200-degree field of view. 1924 x 1556 pixels
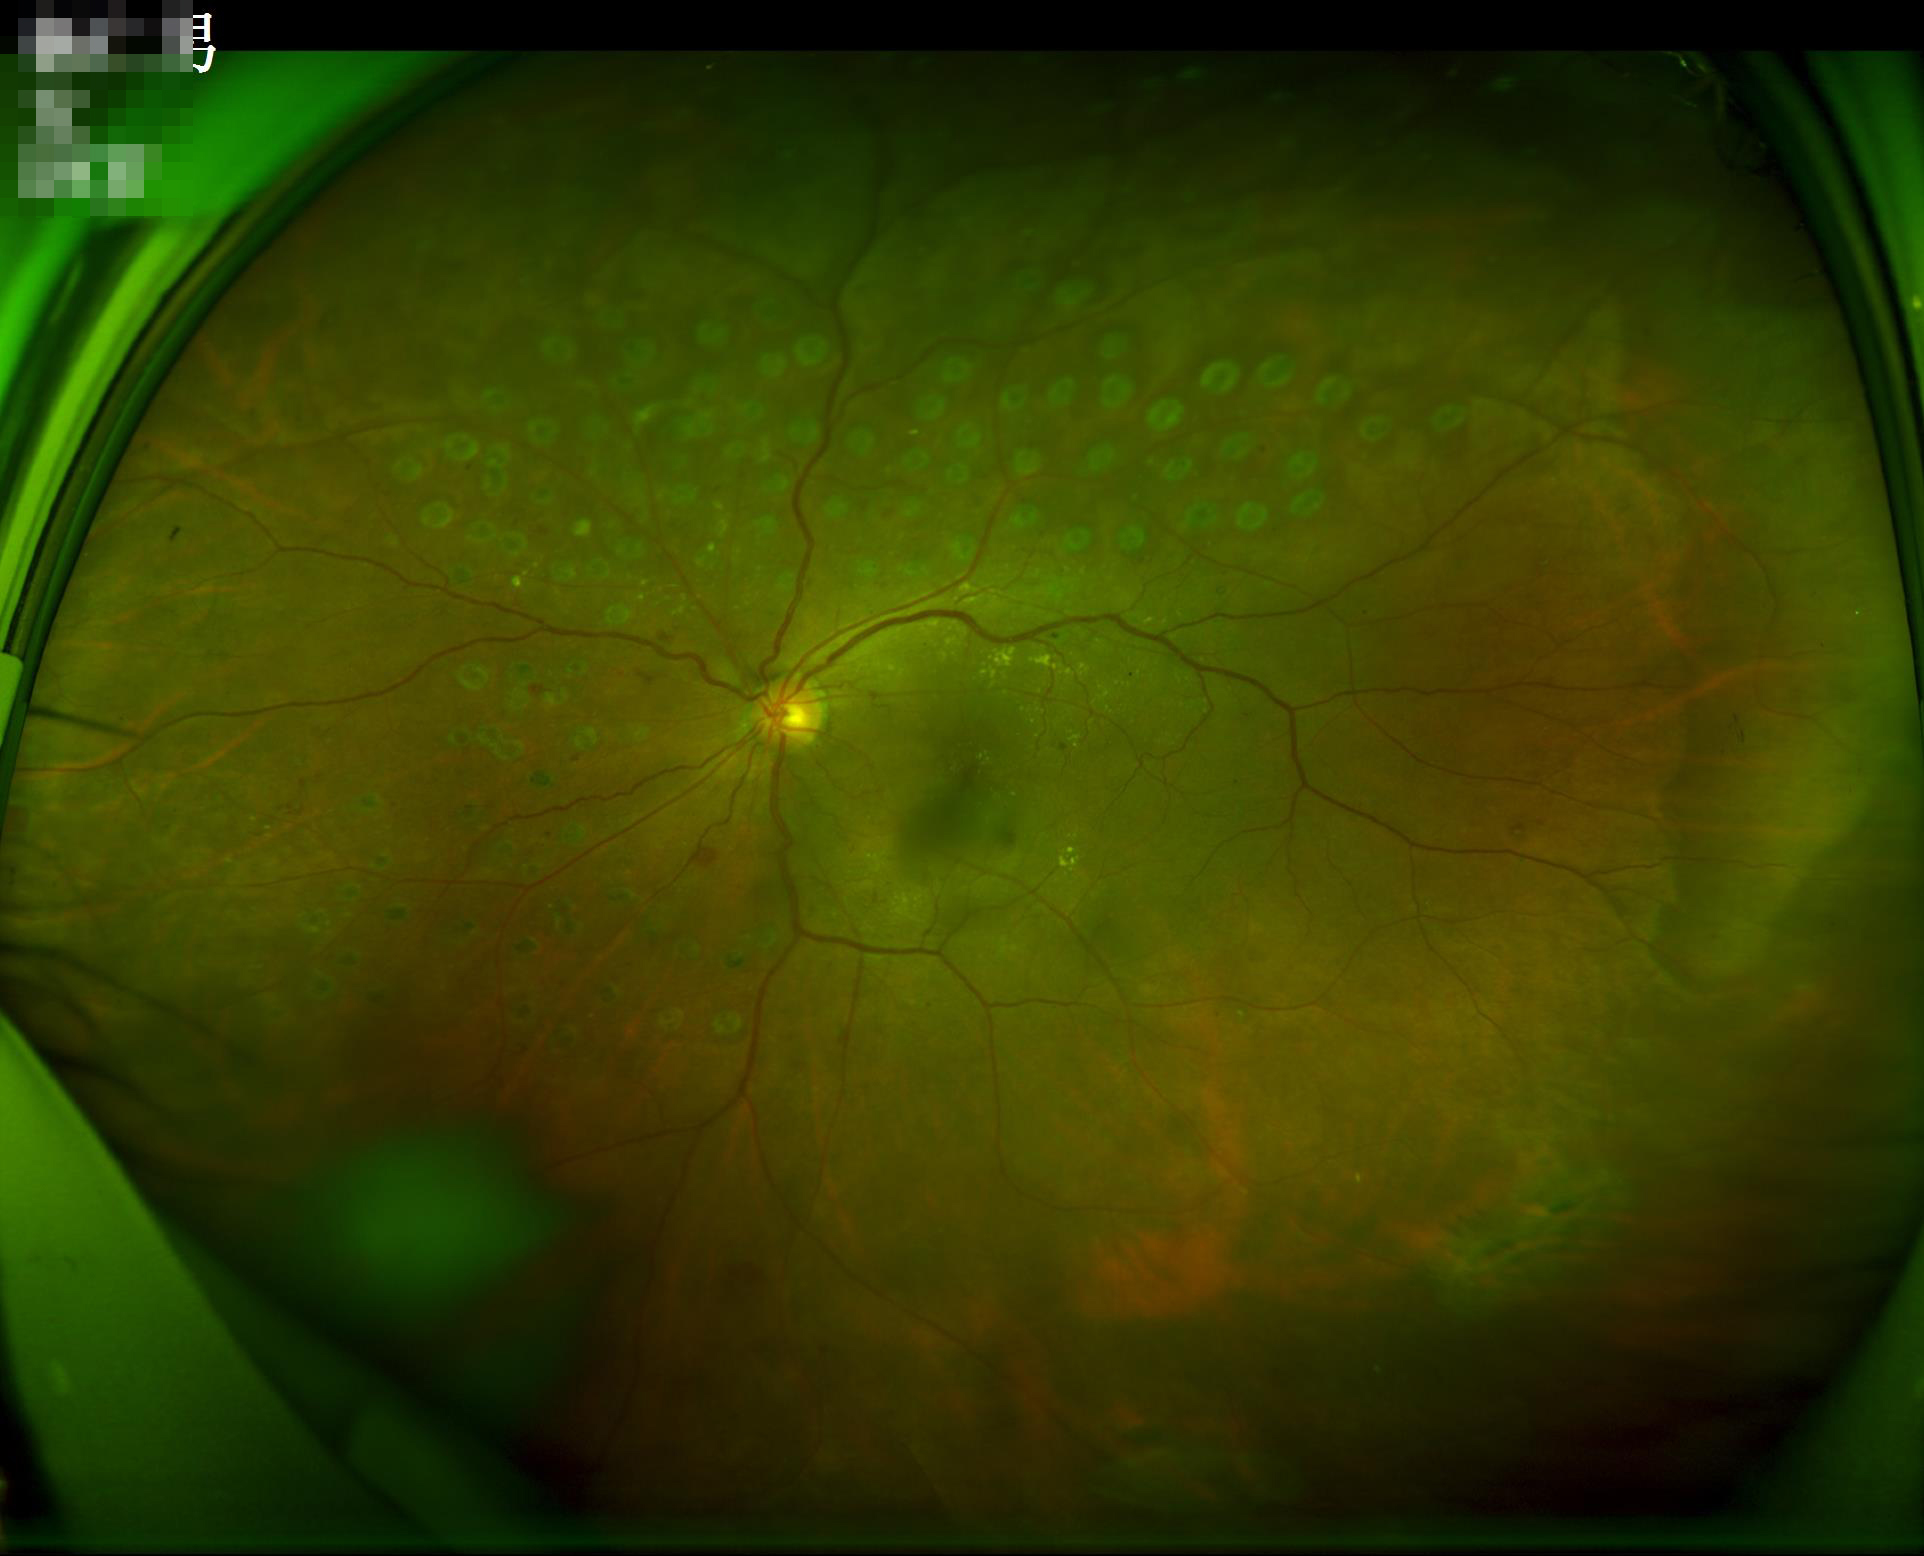
illumination: even and well-balanced
overall_quality: adequate for clinical interpretation
contrast: good dynamic range